FOV: 45 degrees · color fundus image
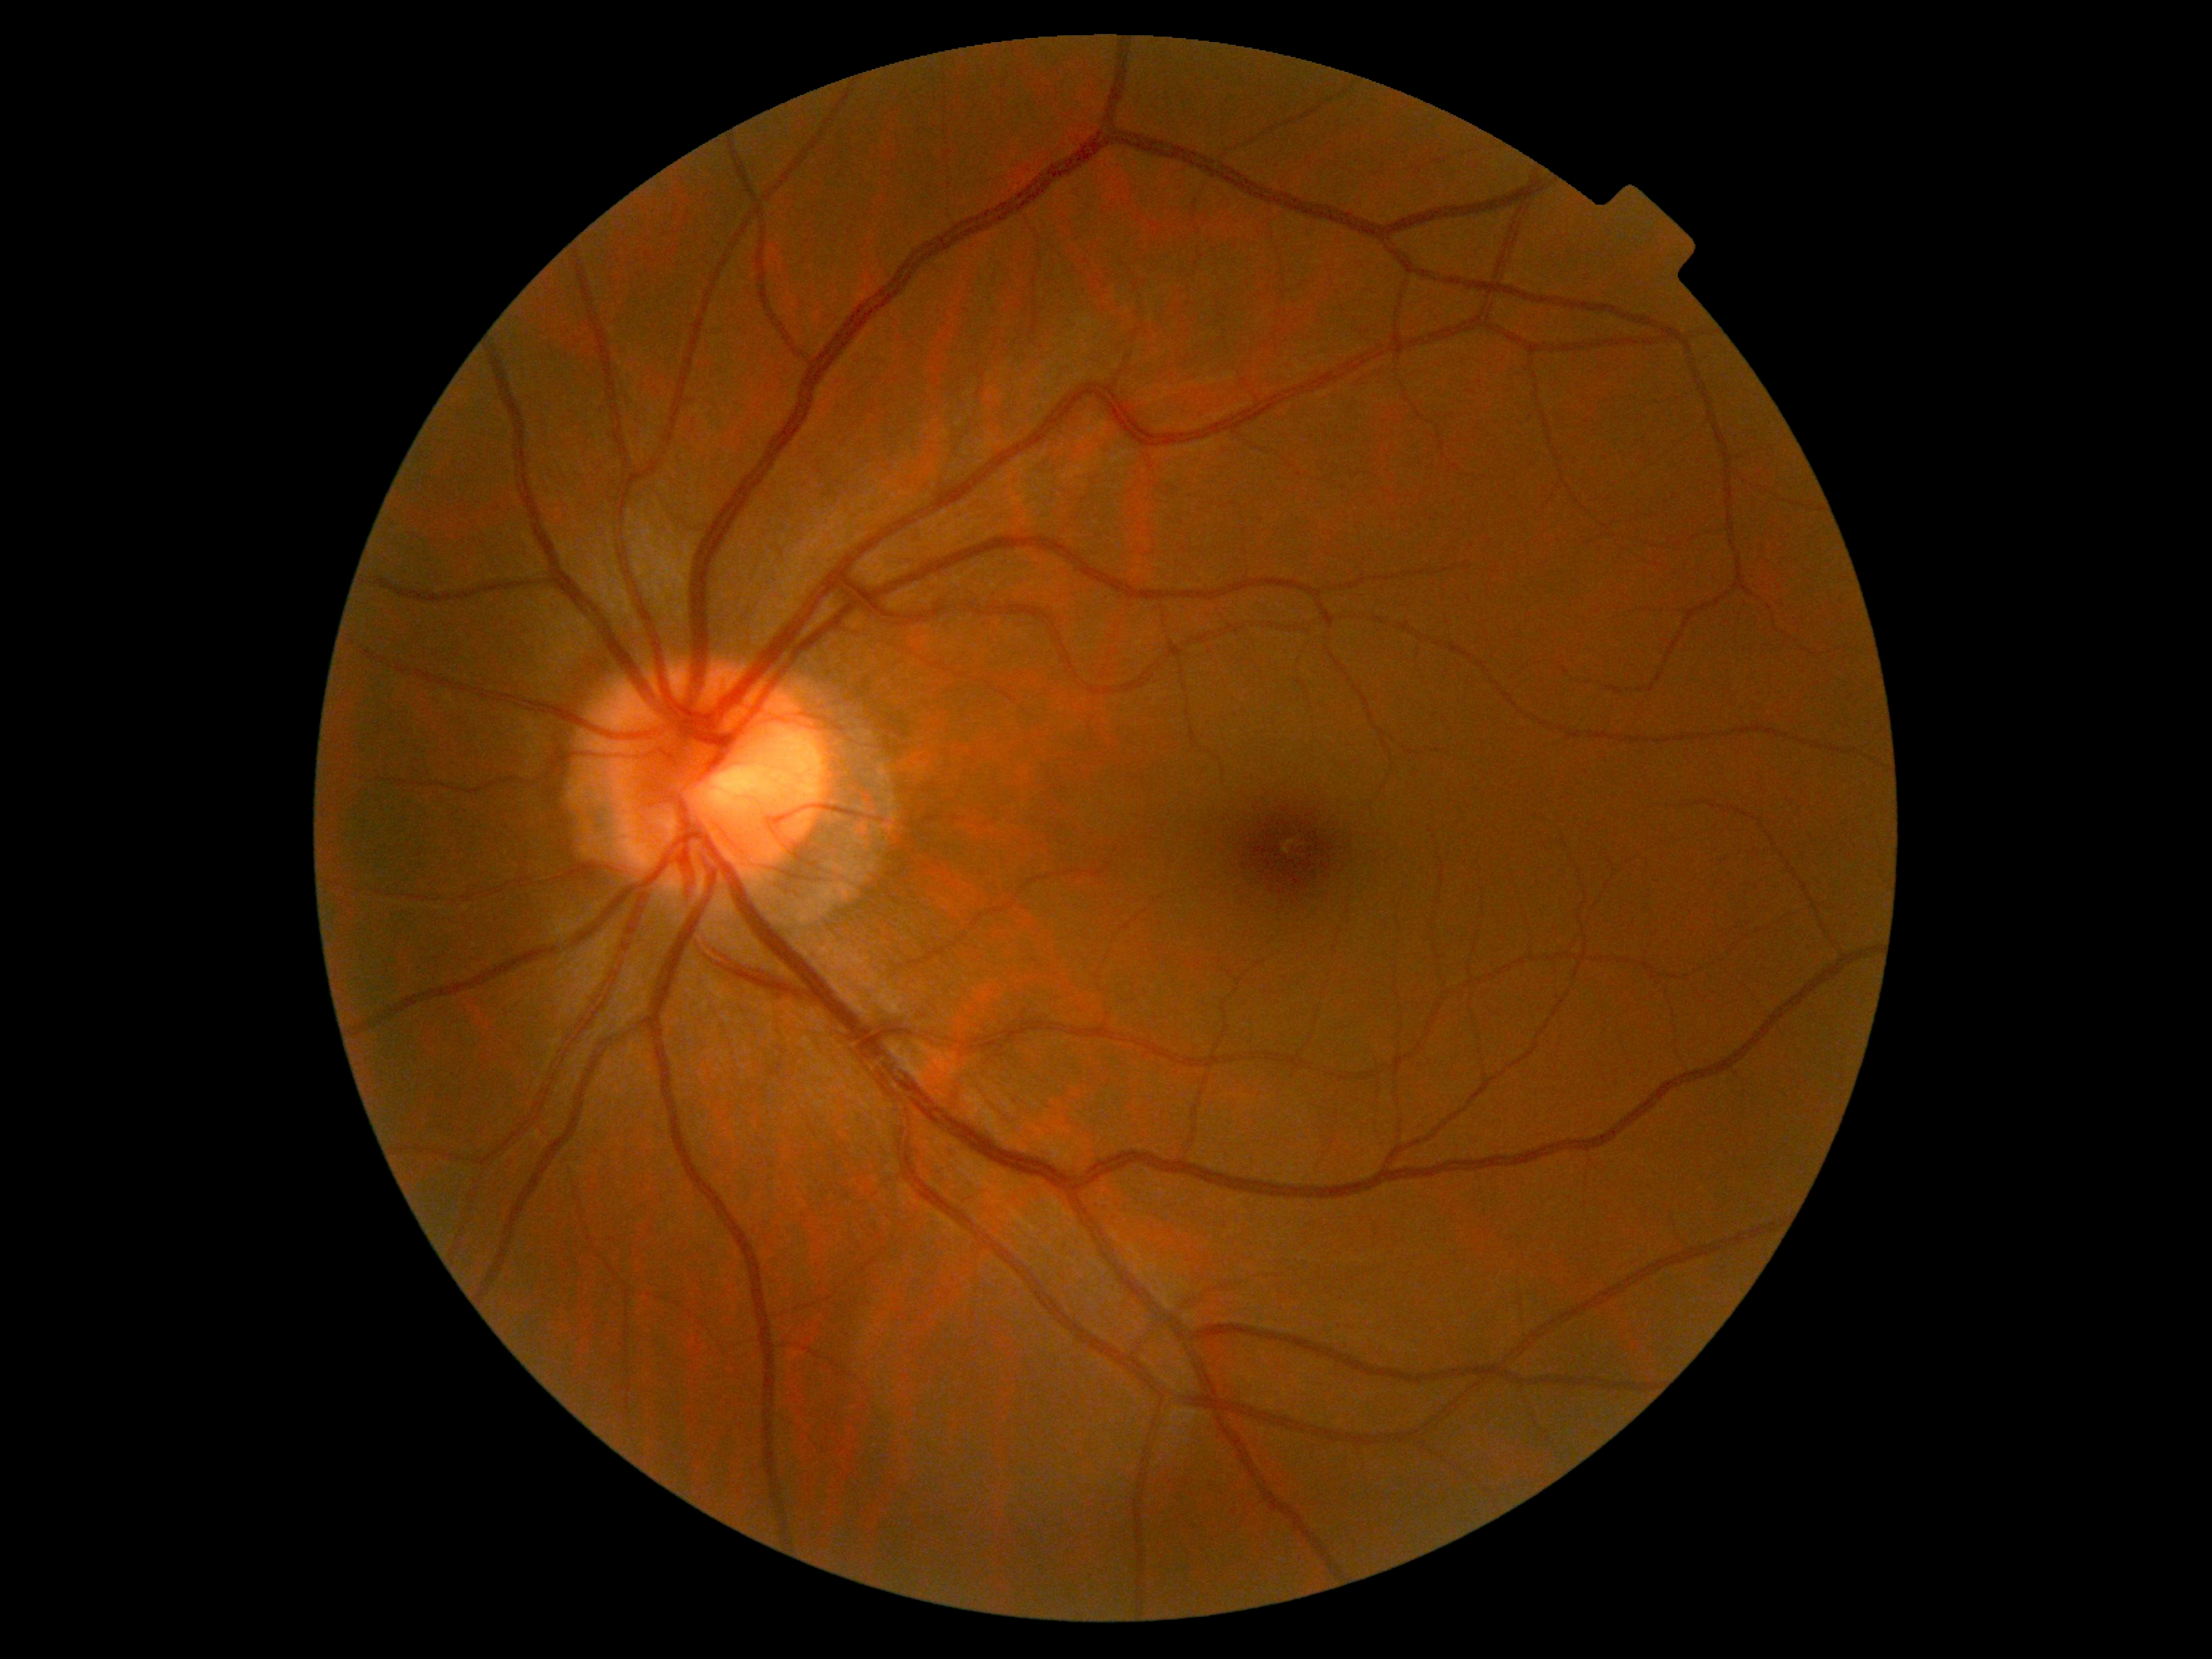   dr_grade: no apparent diabetic retinopathy (grade 0)
  dr_impression: no signs of DR